Fundus photo; 45° field of view; 2352 by 1568 pixels
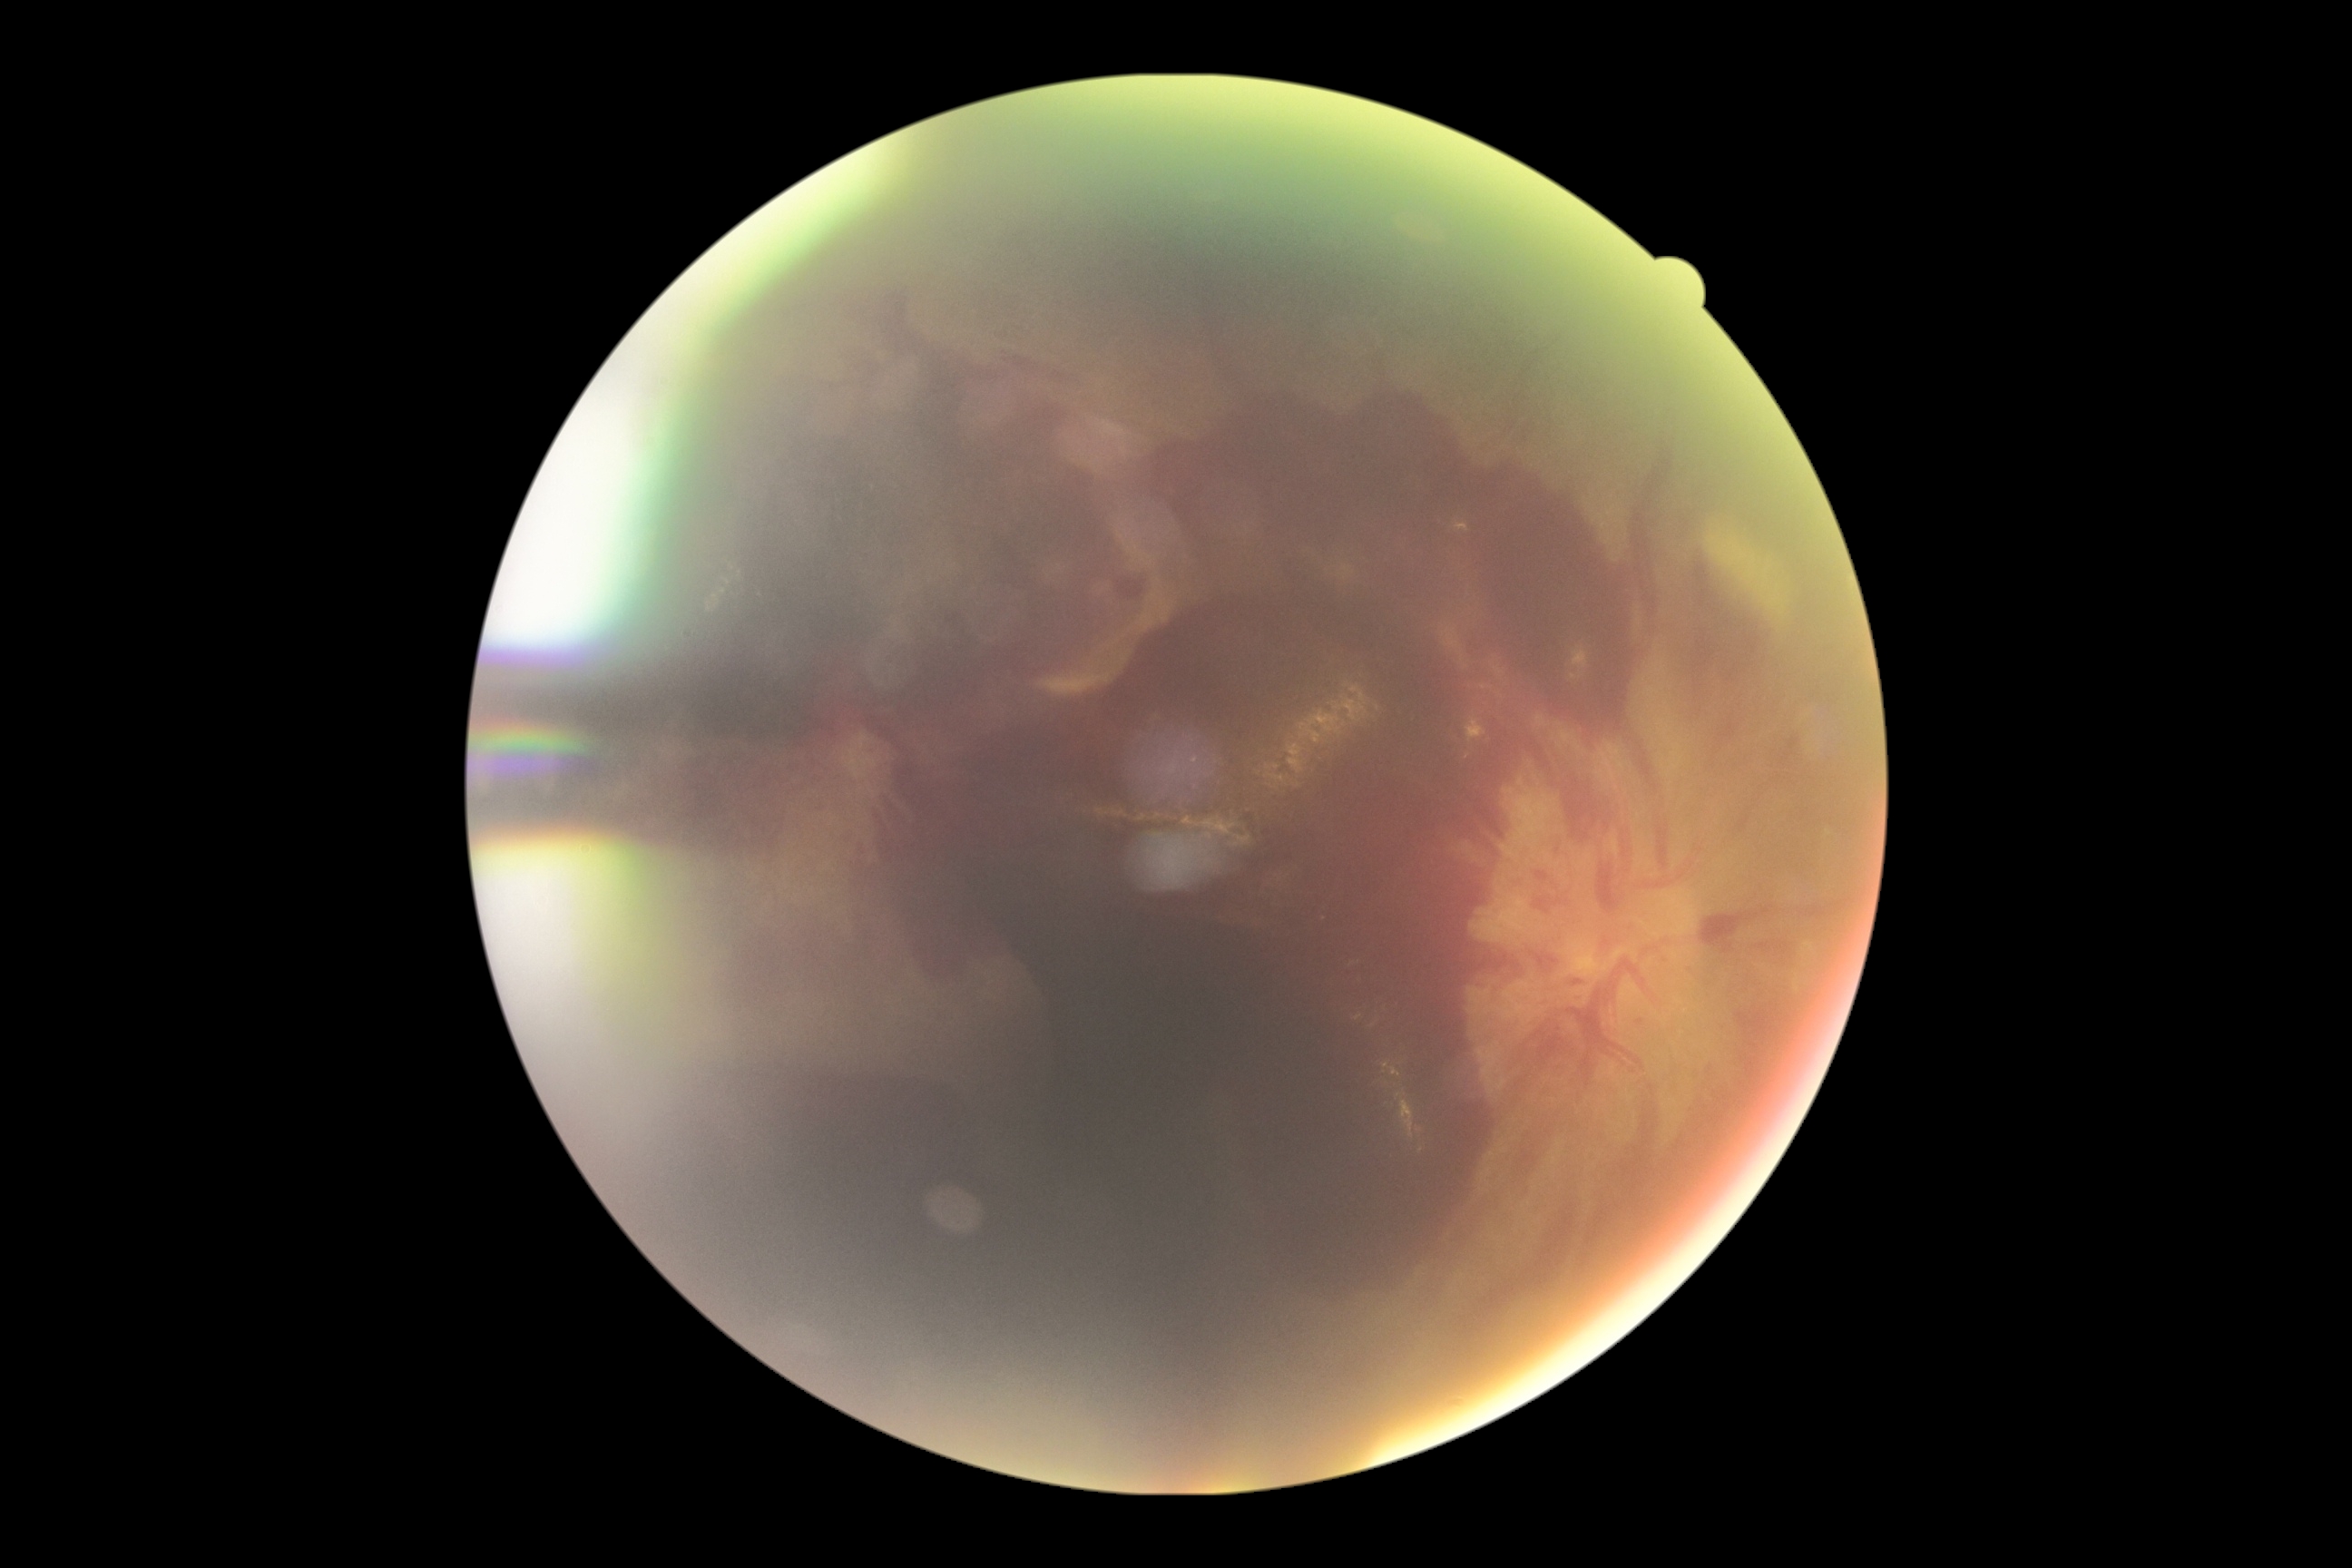

Diabetic retinopathy (DR): proliferative diabetic retinopathy (grade 4).